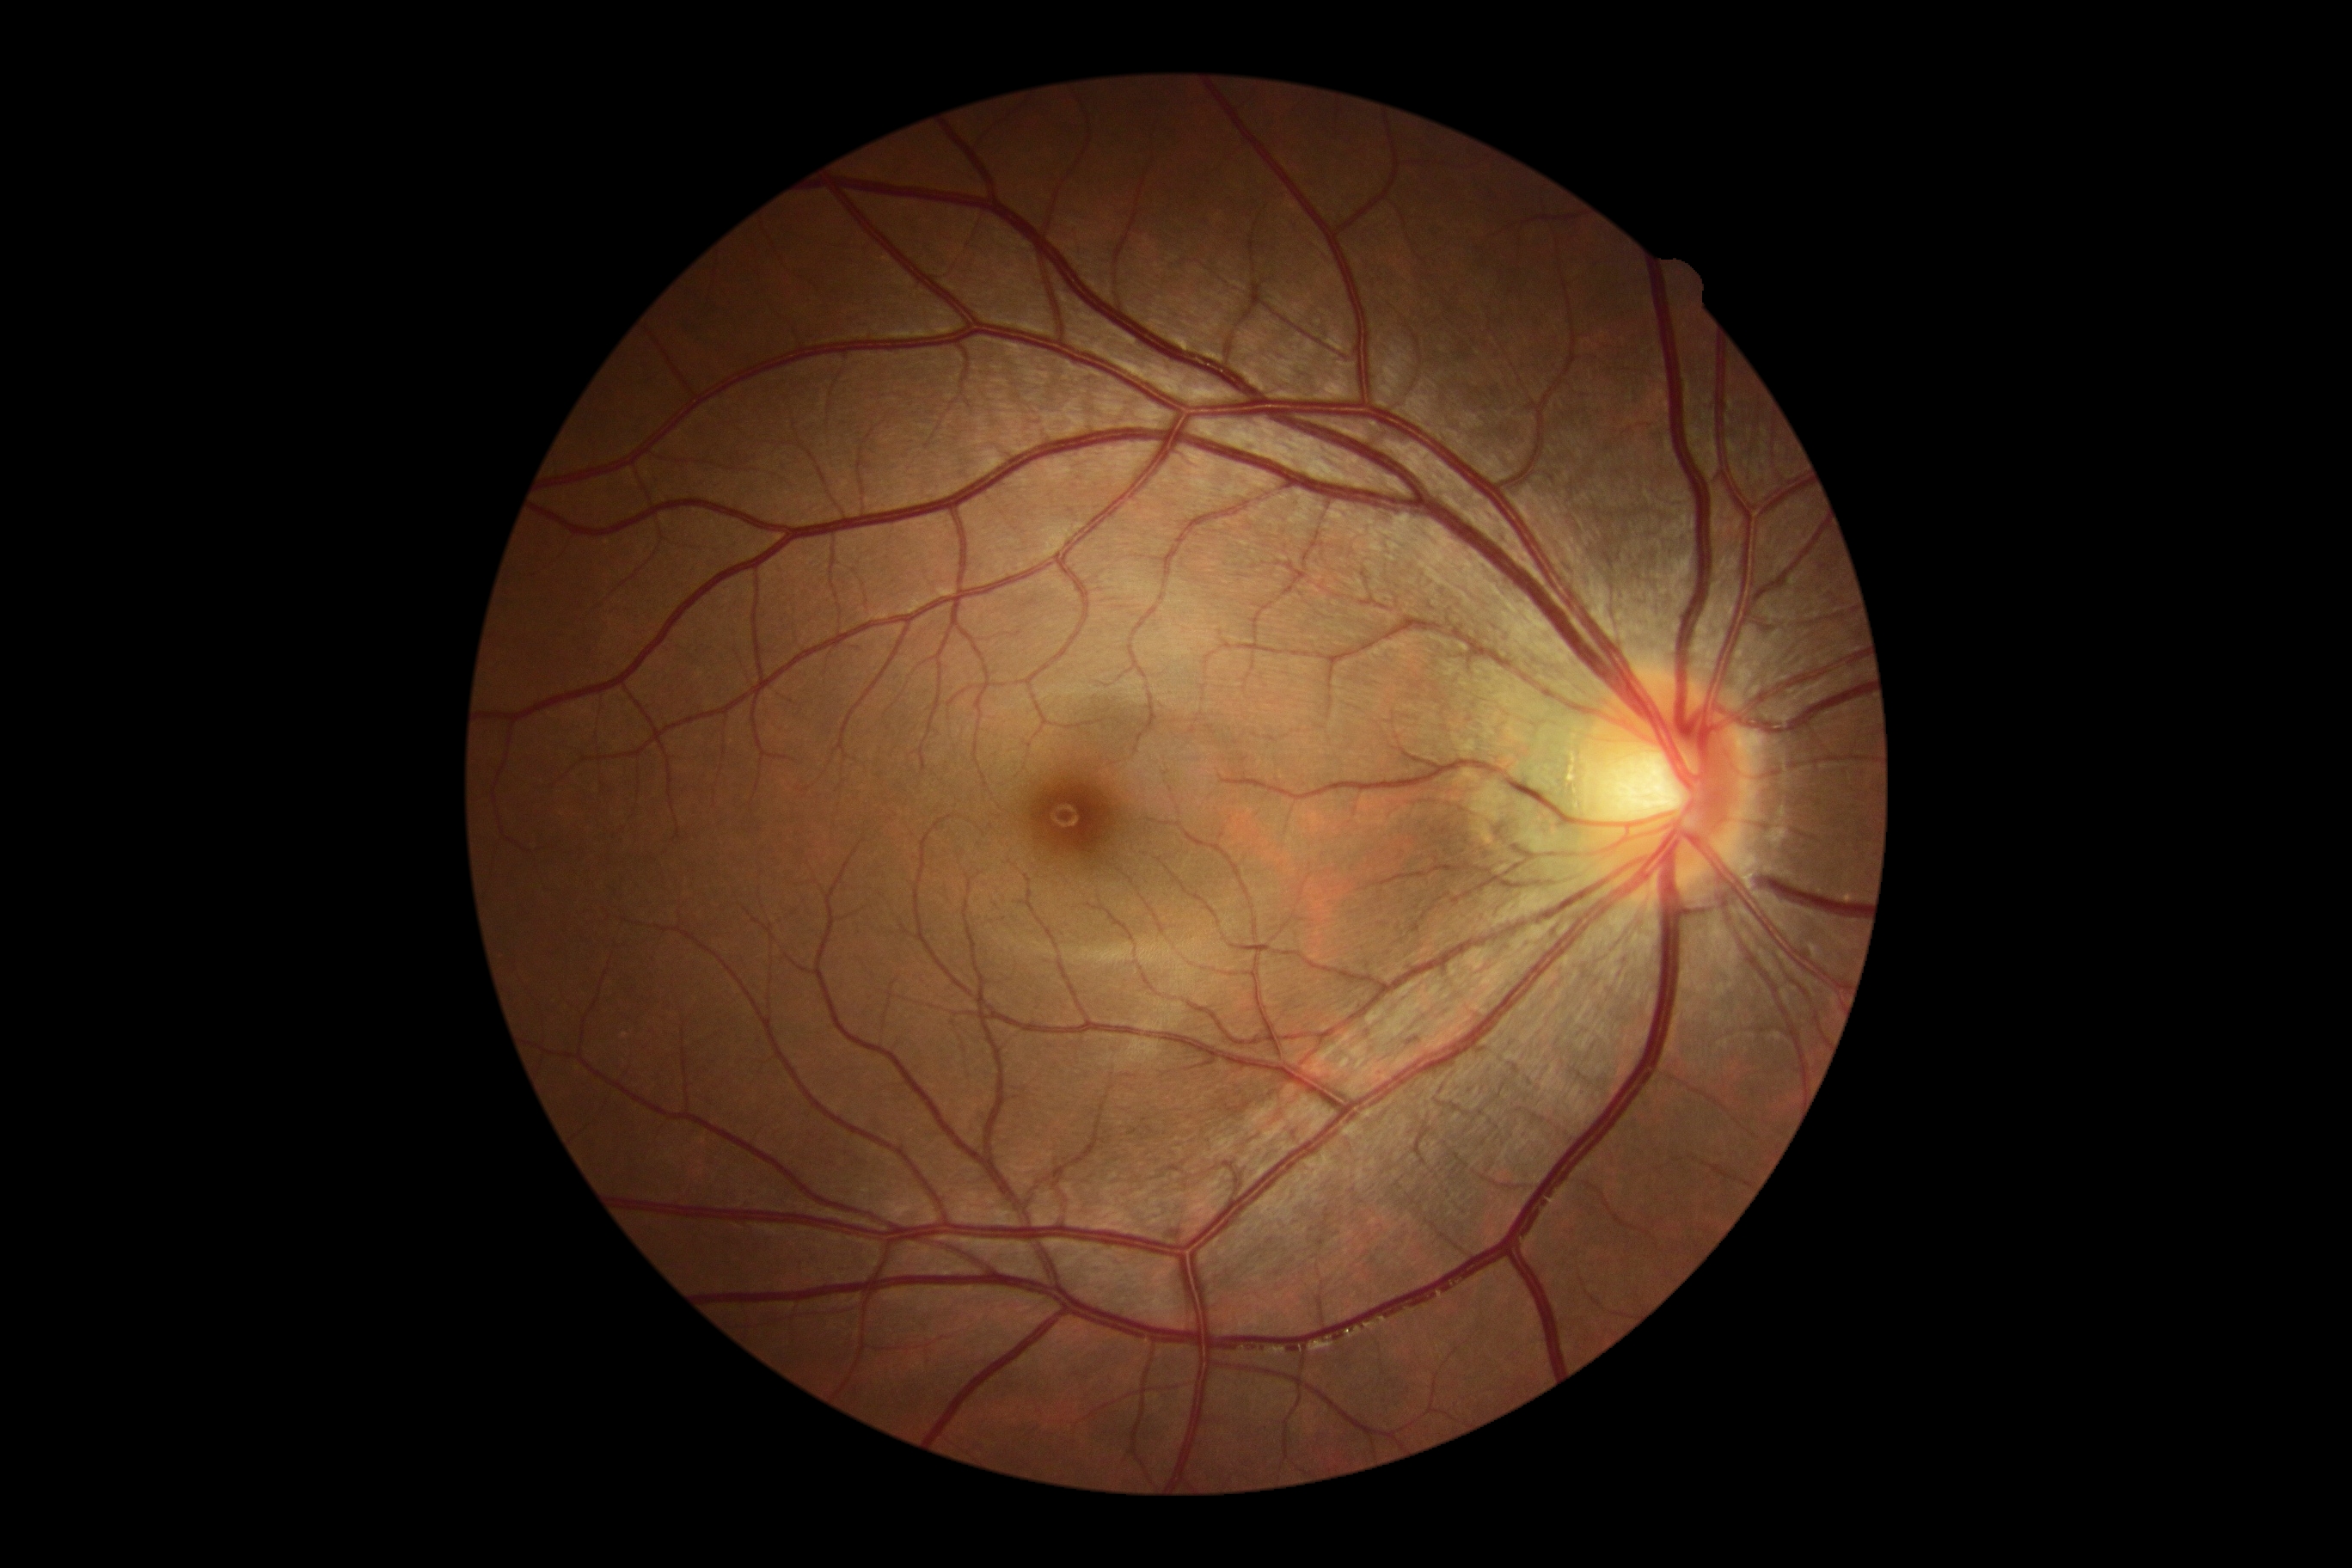 DR severity: 0/4